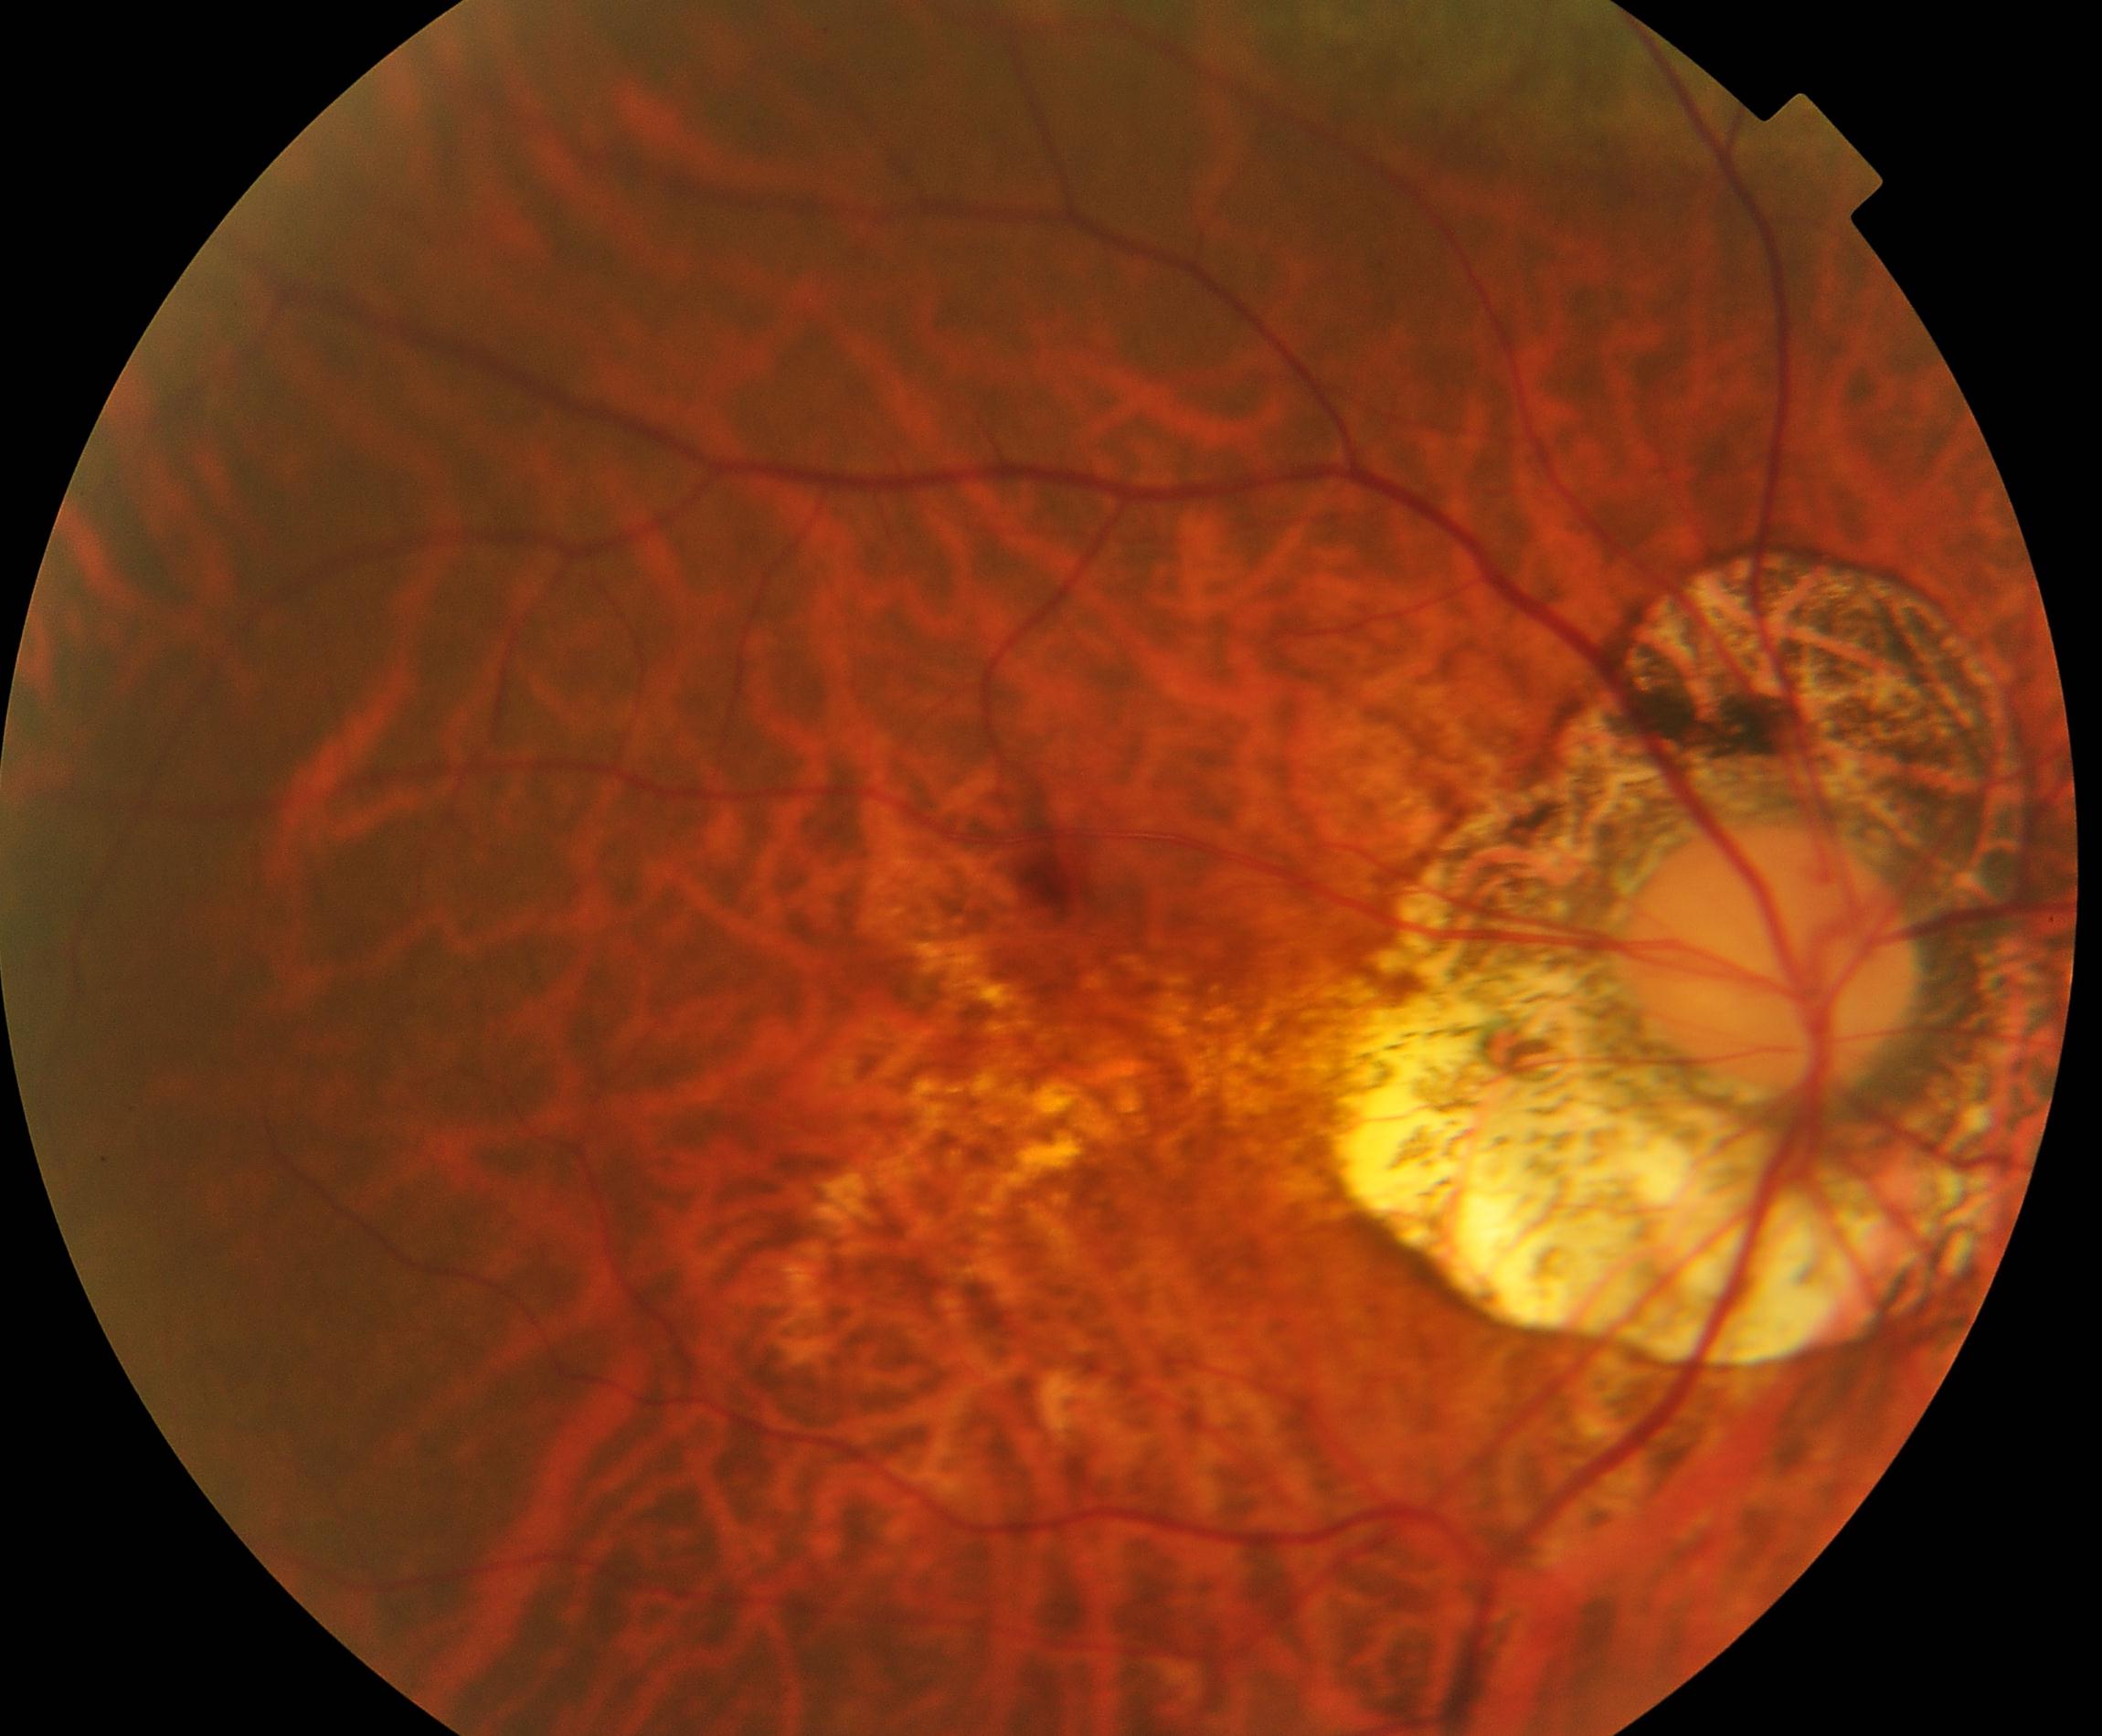

Color fundus photograph showing pathological myopia.